2352 by 1568 pixels: 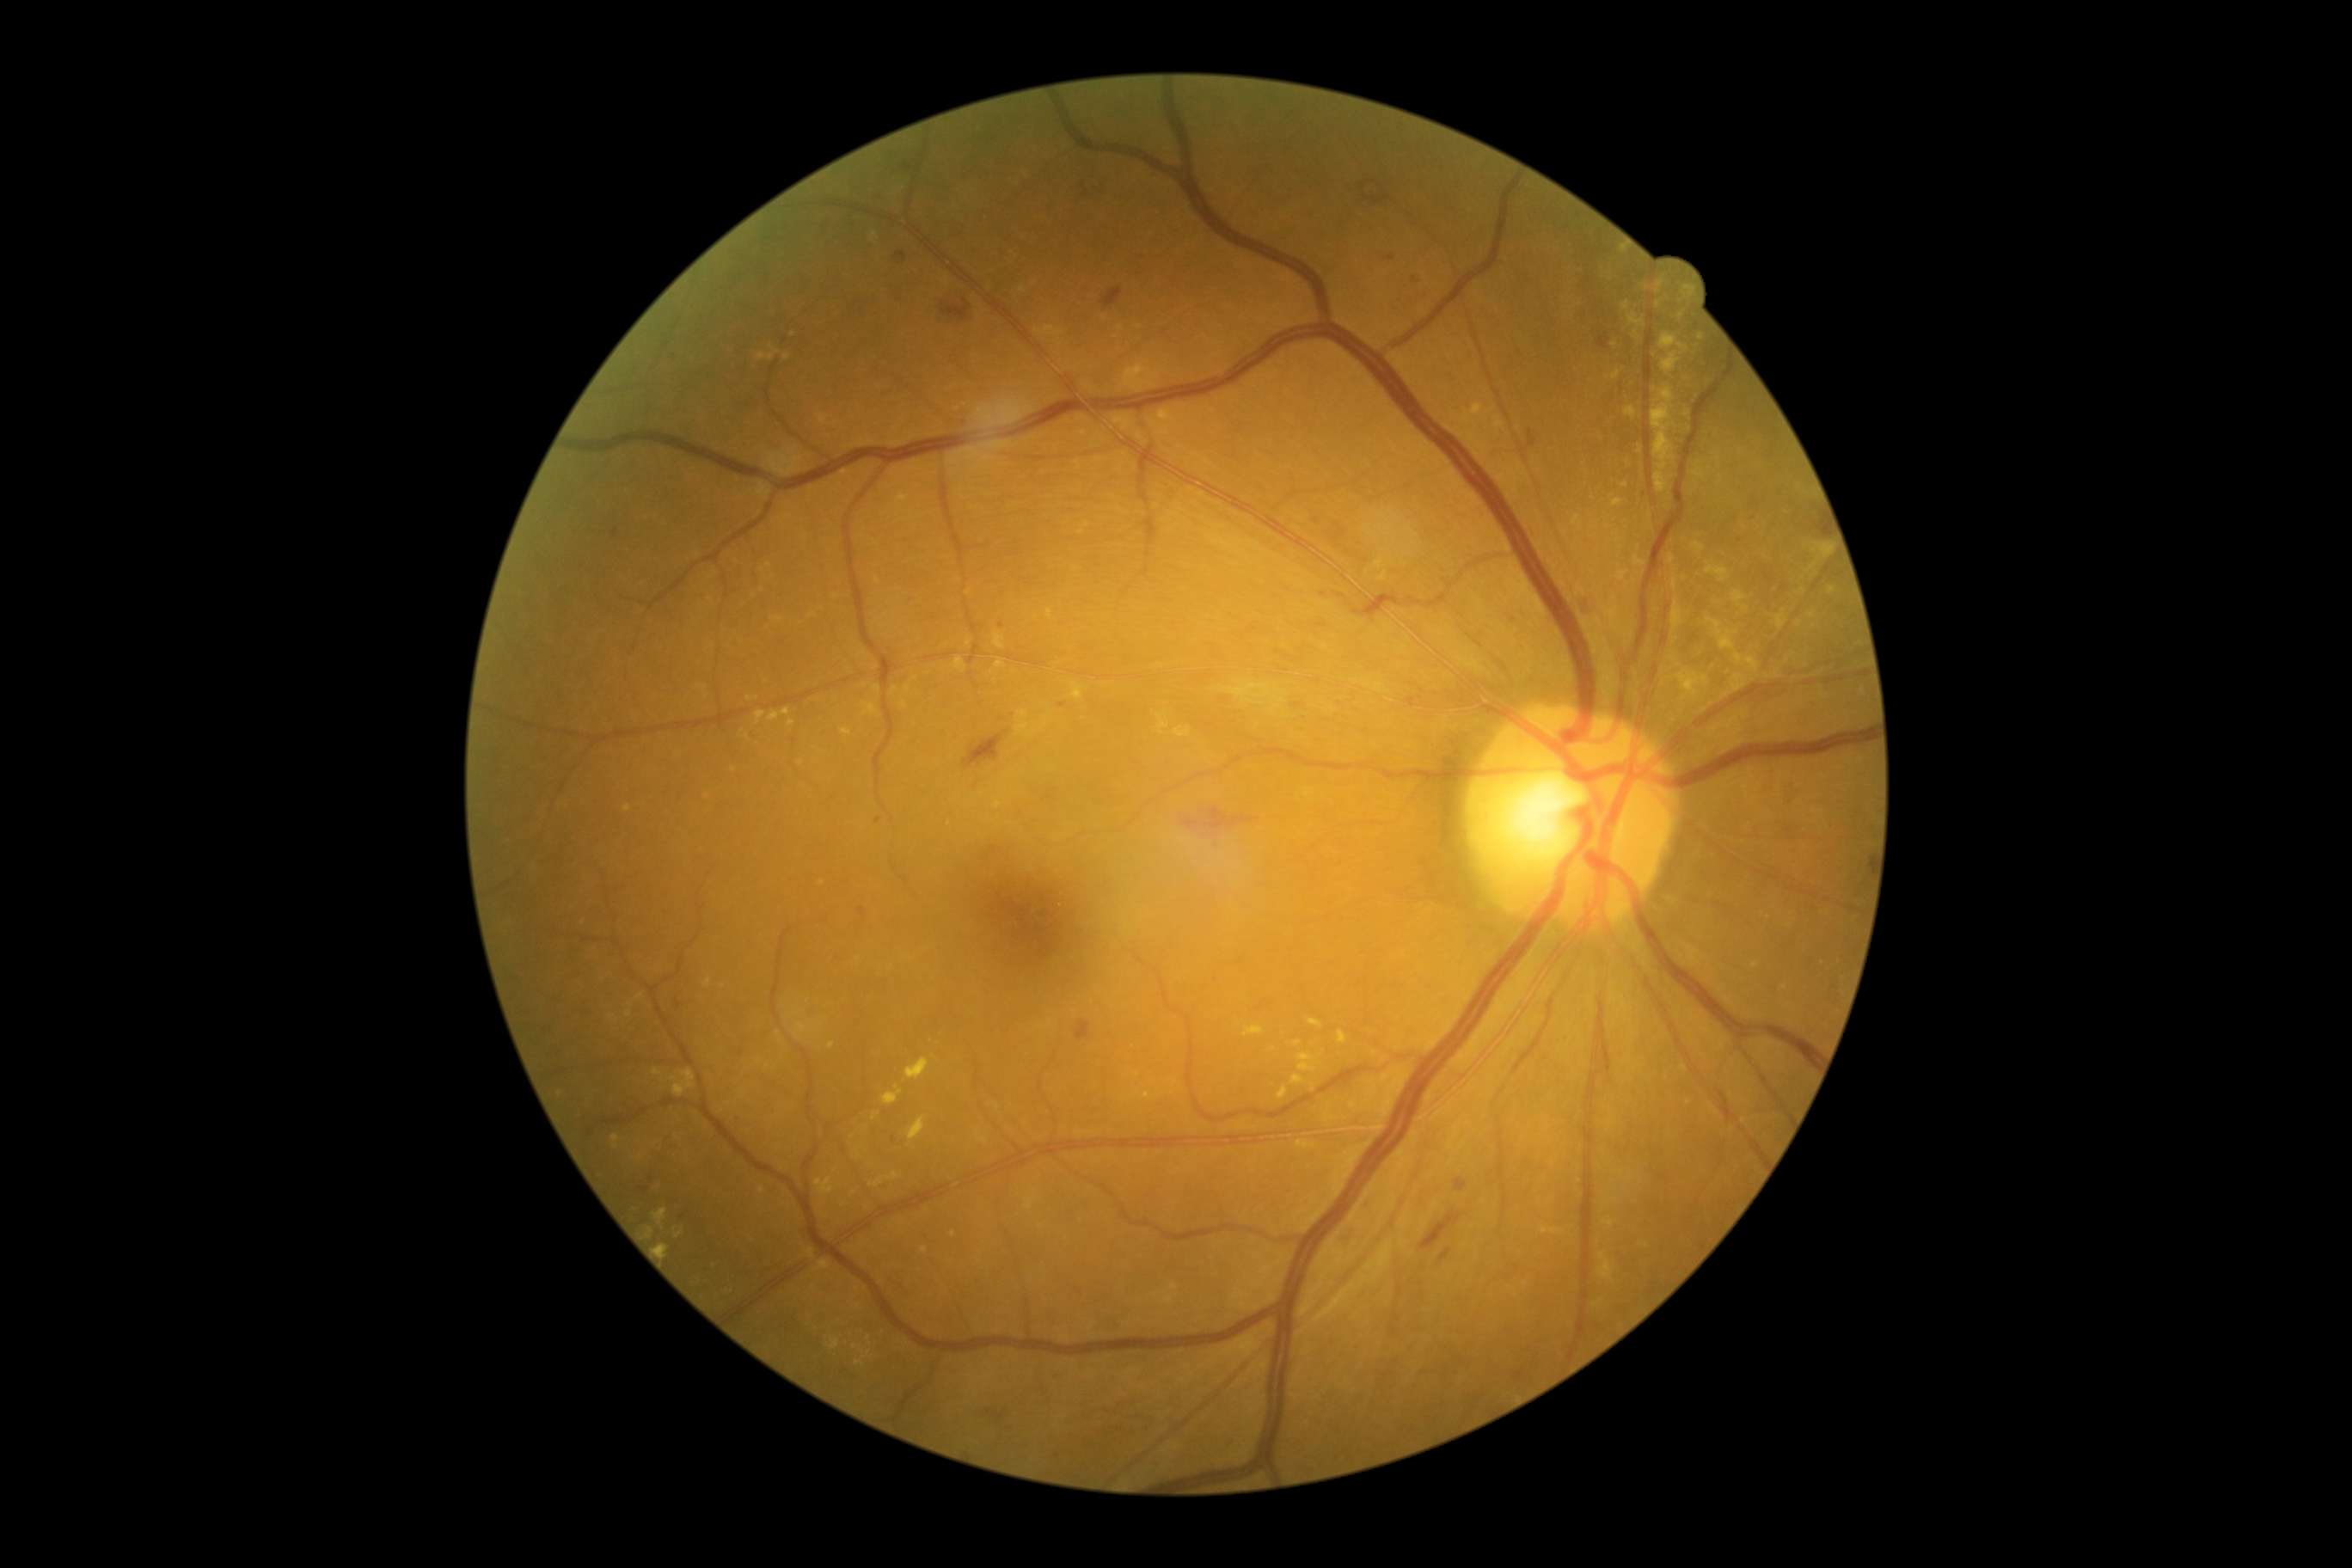

{"partial":true,"dr_grade":2,"lesions":{"ex":[[862,702,881,716],[1572,515,1583,532],[995,661,1007,670],[900,701,907,709],[1669,554,1675,567],[1660,333,1689,353],[897,493,907,505],[855,1352,871,1366],[1810,542,1835,561],[658,1246,670,1258]],"ex_small_approx":[[868,1338],[1687,415],[1786,720],[846,1343],[1765,558],[1597,527],[1800,625],[915,679]]}}